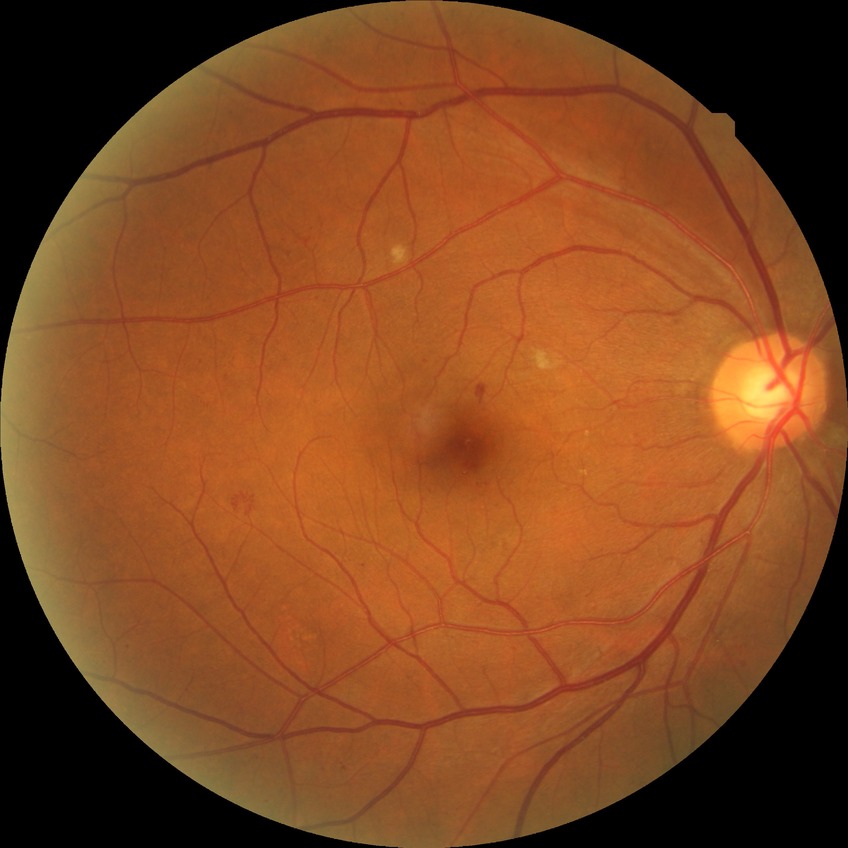 diabetic retinopathy (DR) = SDR (simple diabetic retinopathy)